Infant wide-field retinal image: 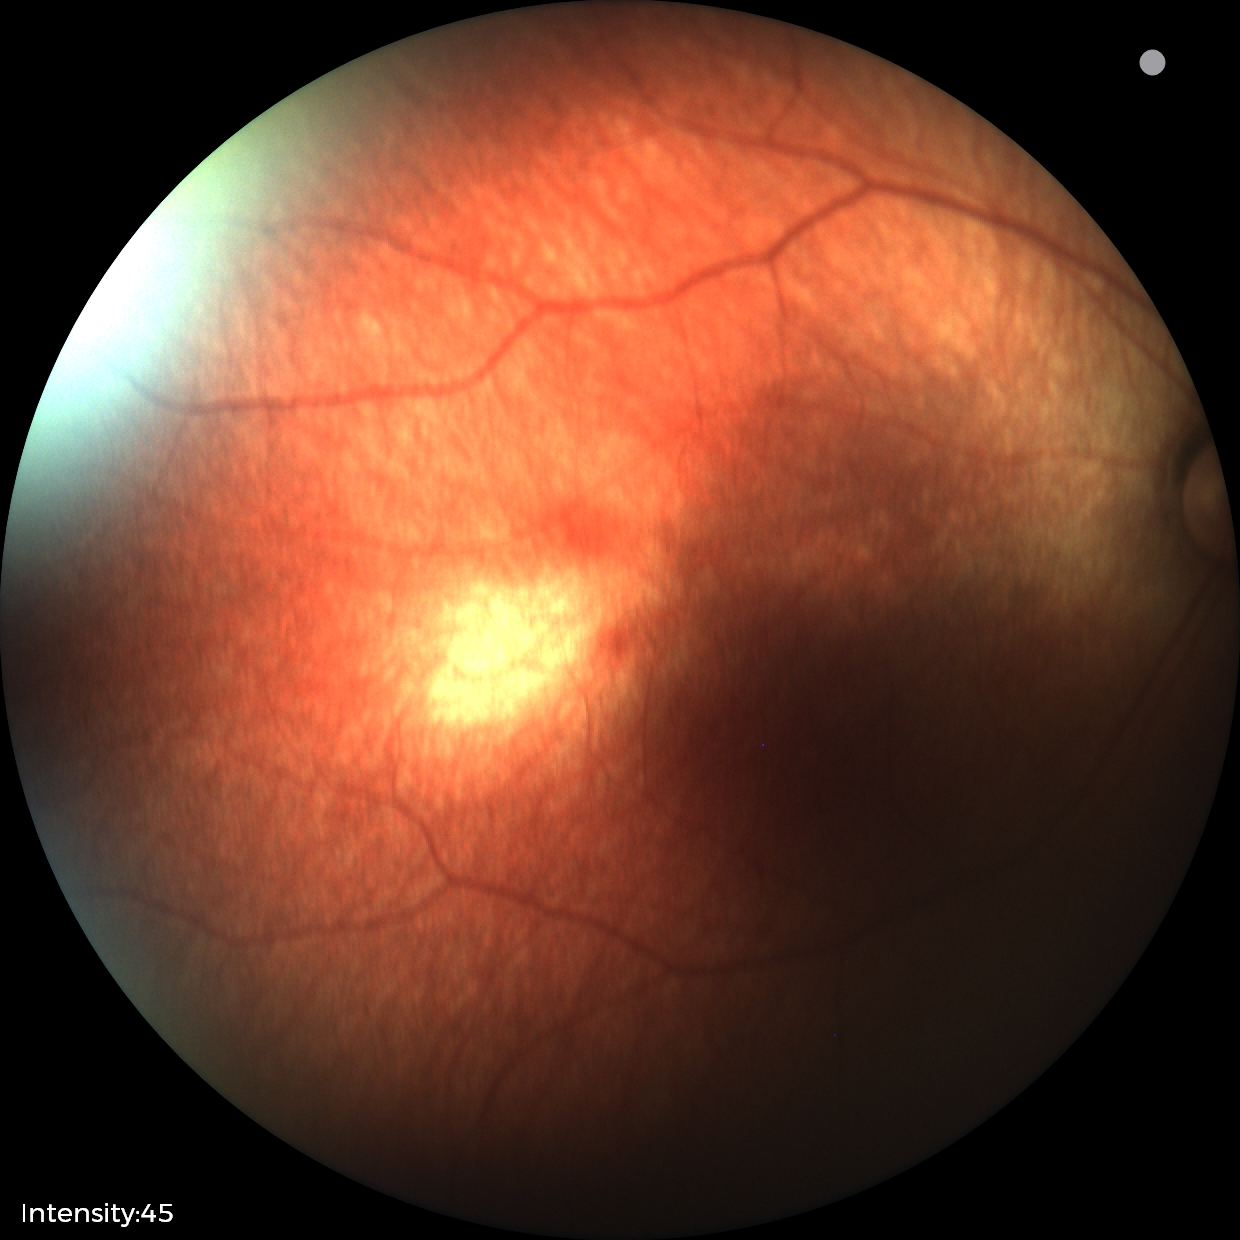 Normal screening examination.